Image size 1380x1382.
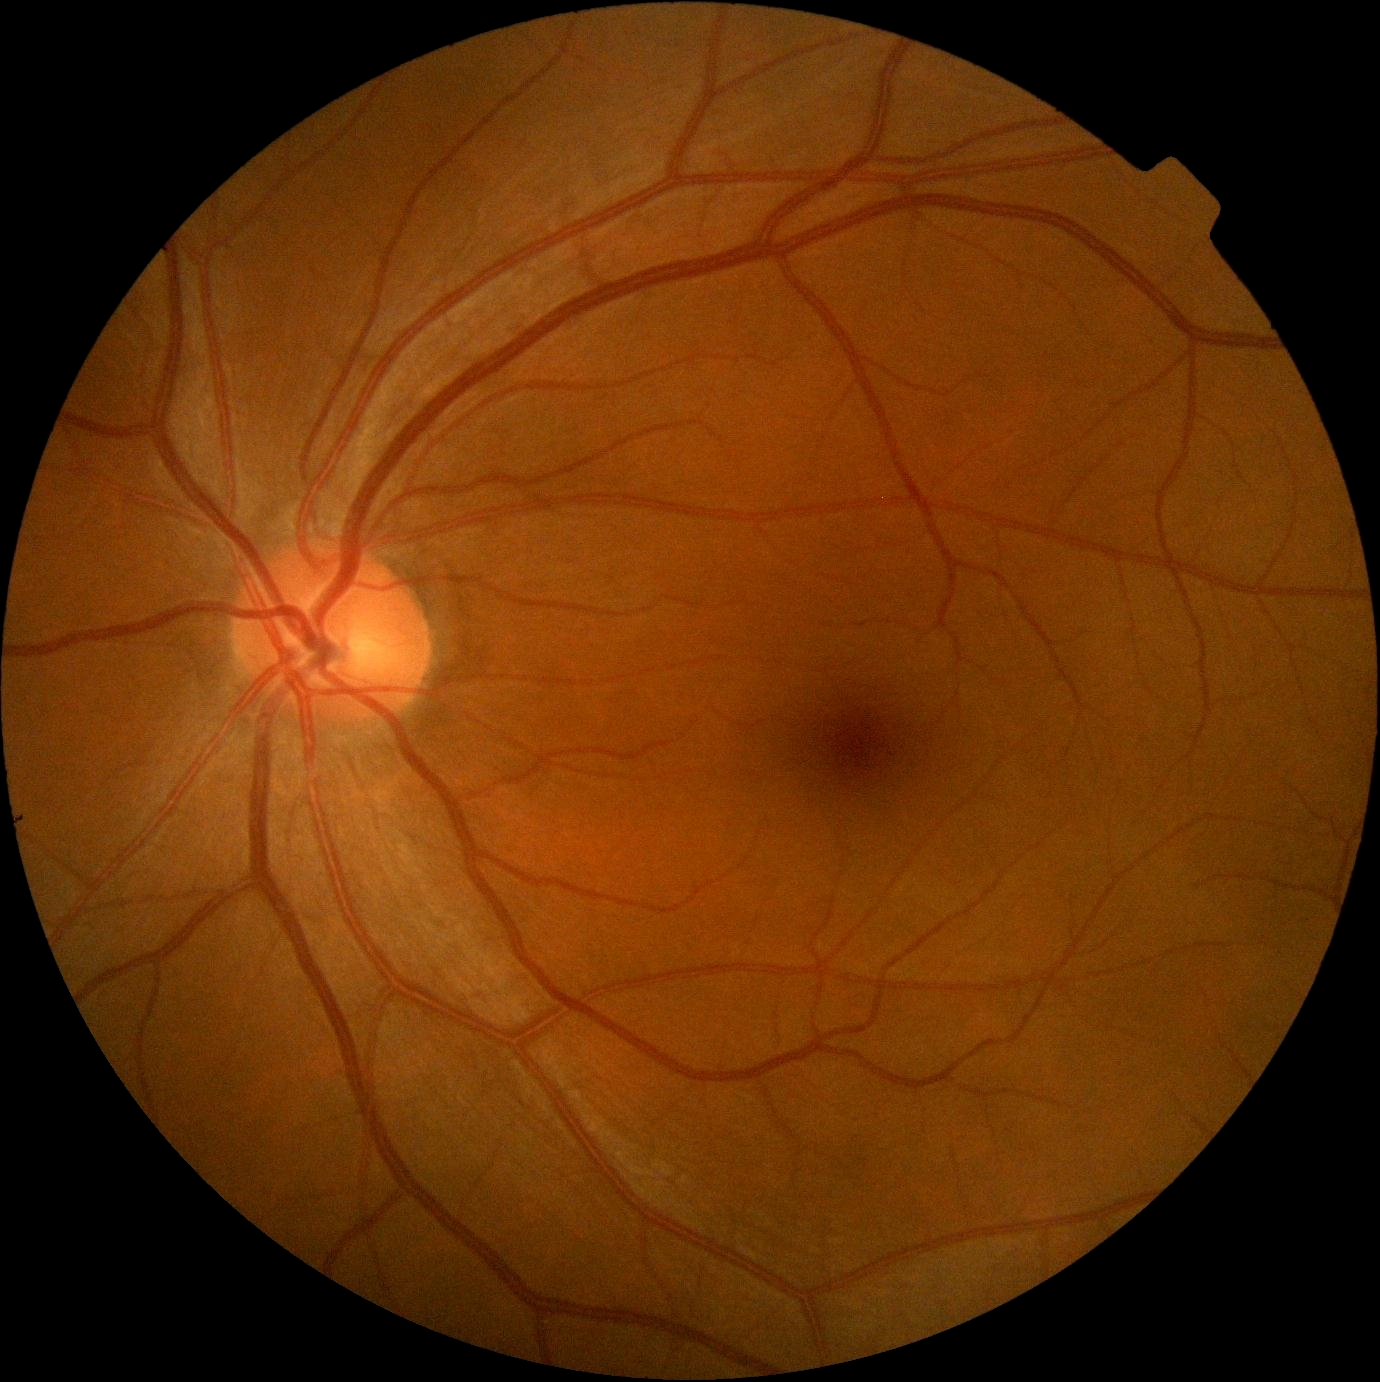

Retinopathy: grade 0 (no apparent retinopathy). No apparent diabetic retinopathy.